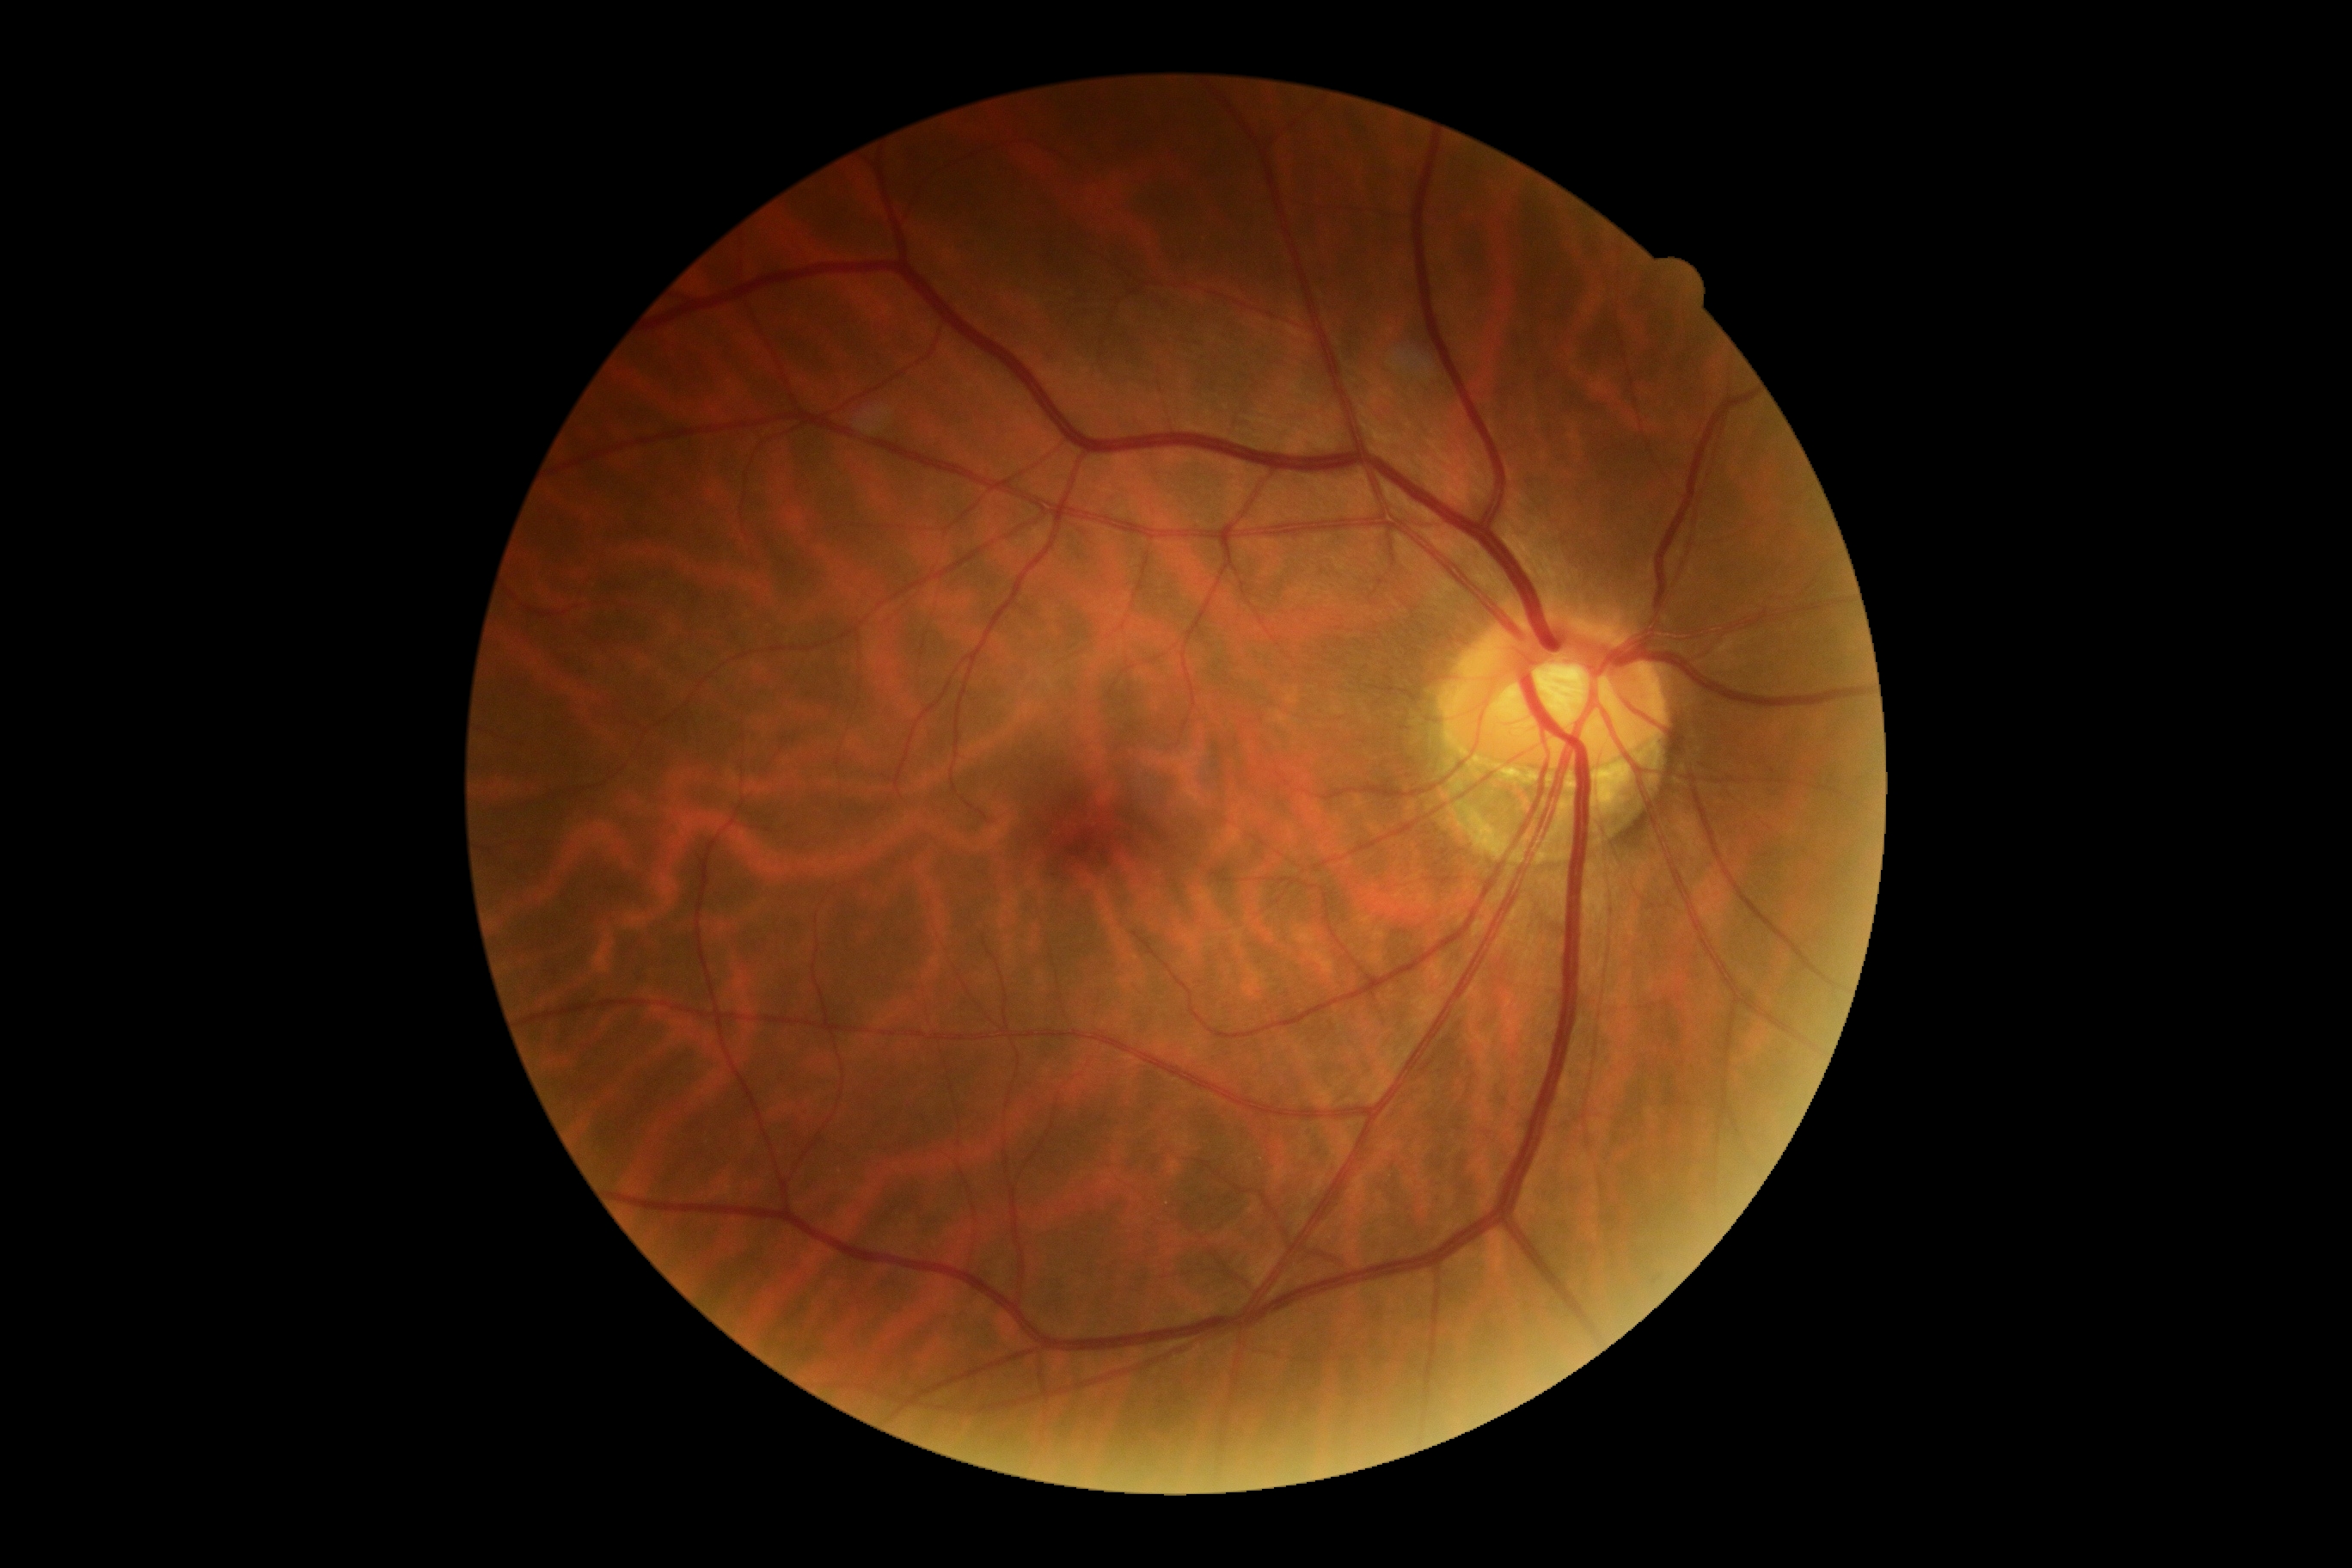
DR severity: grade 0 — no visible signs of diabetic retinopathy.